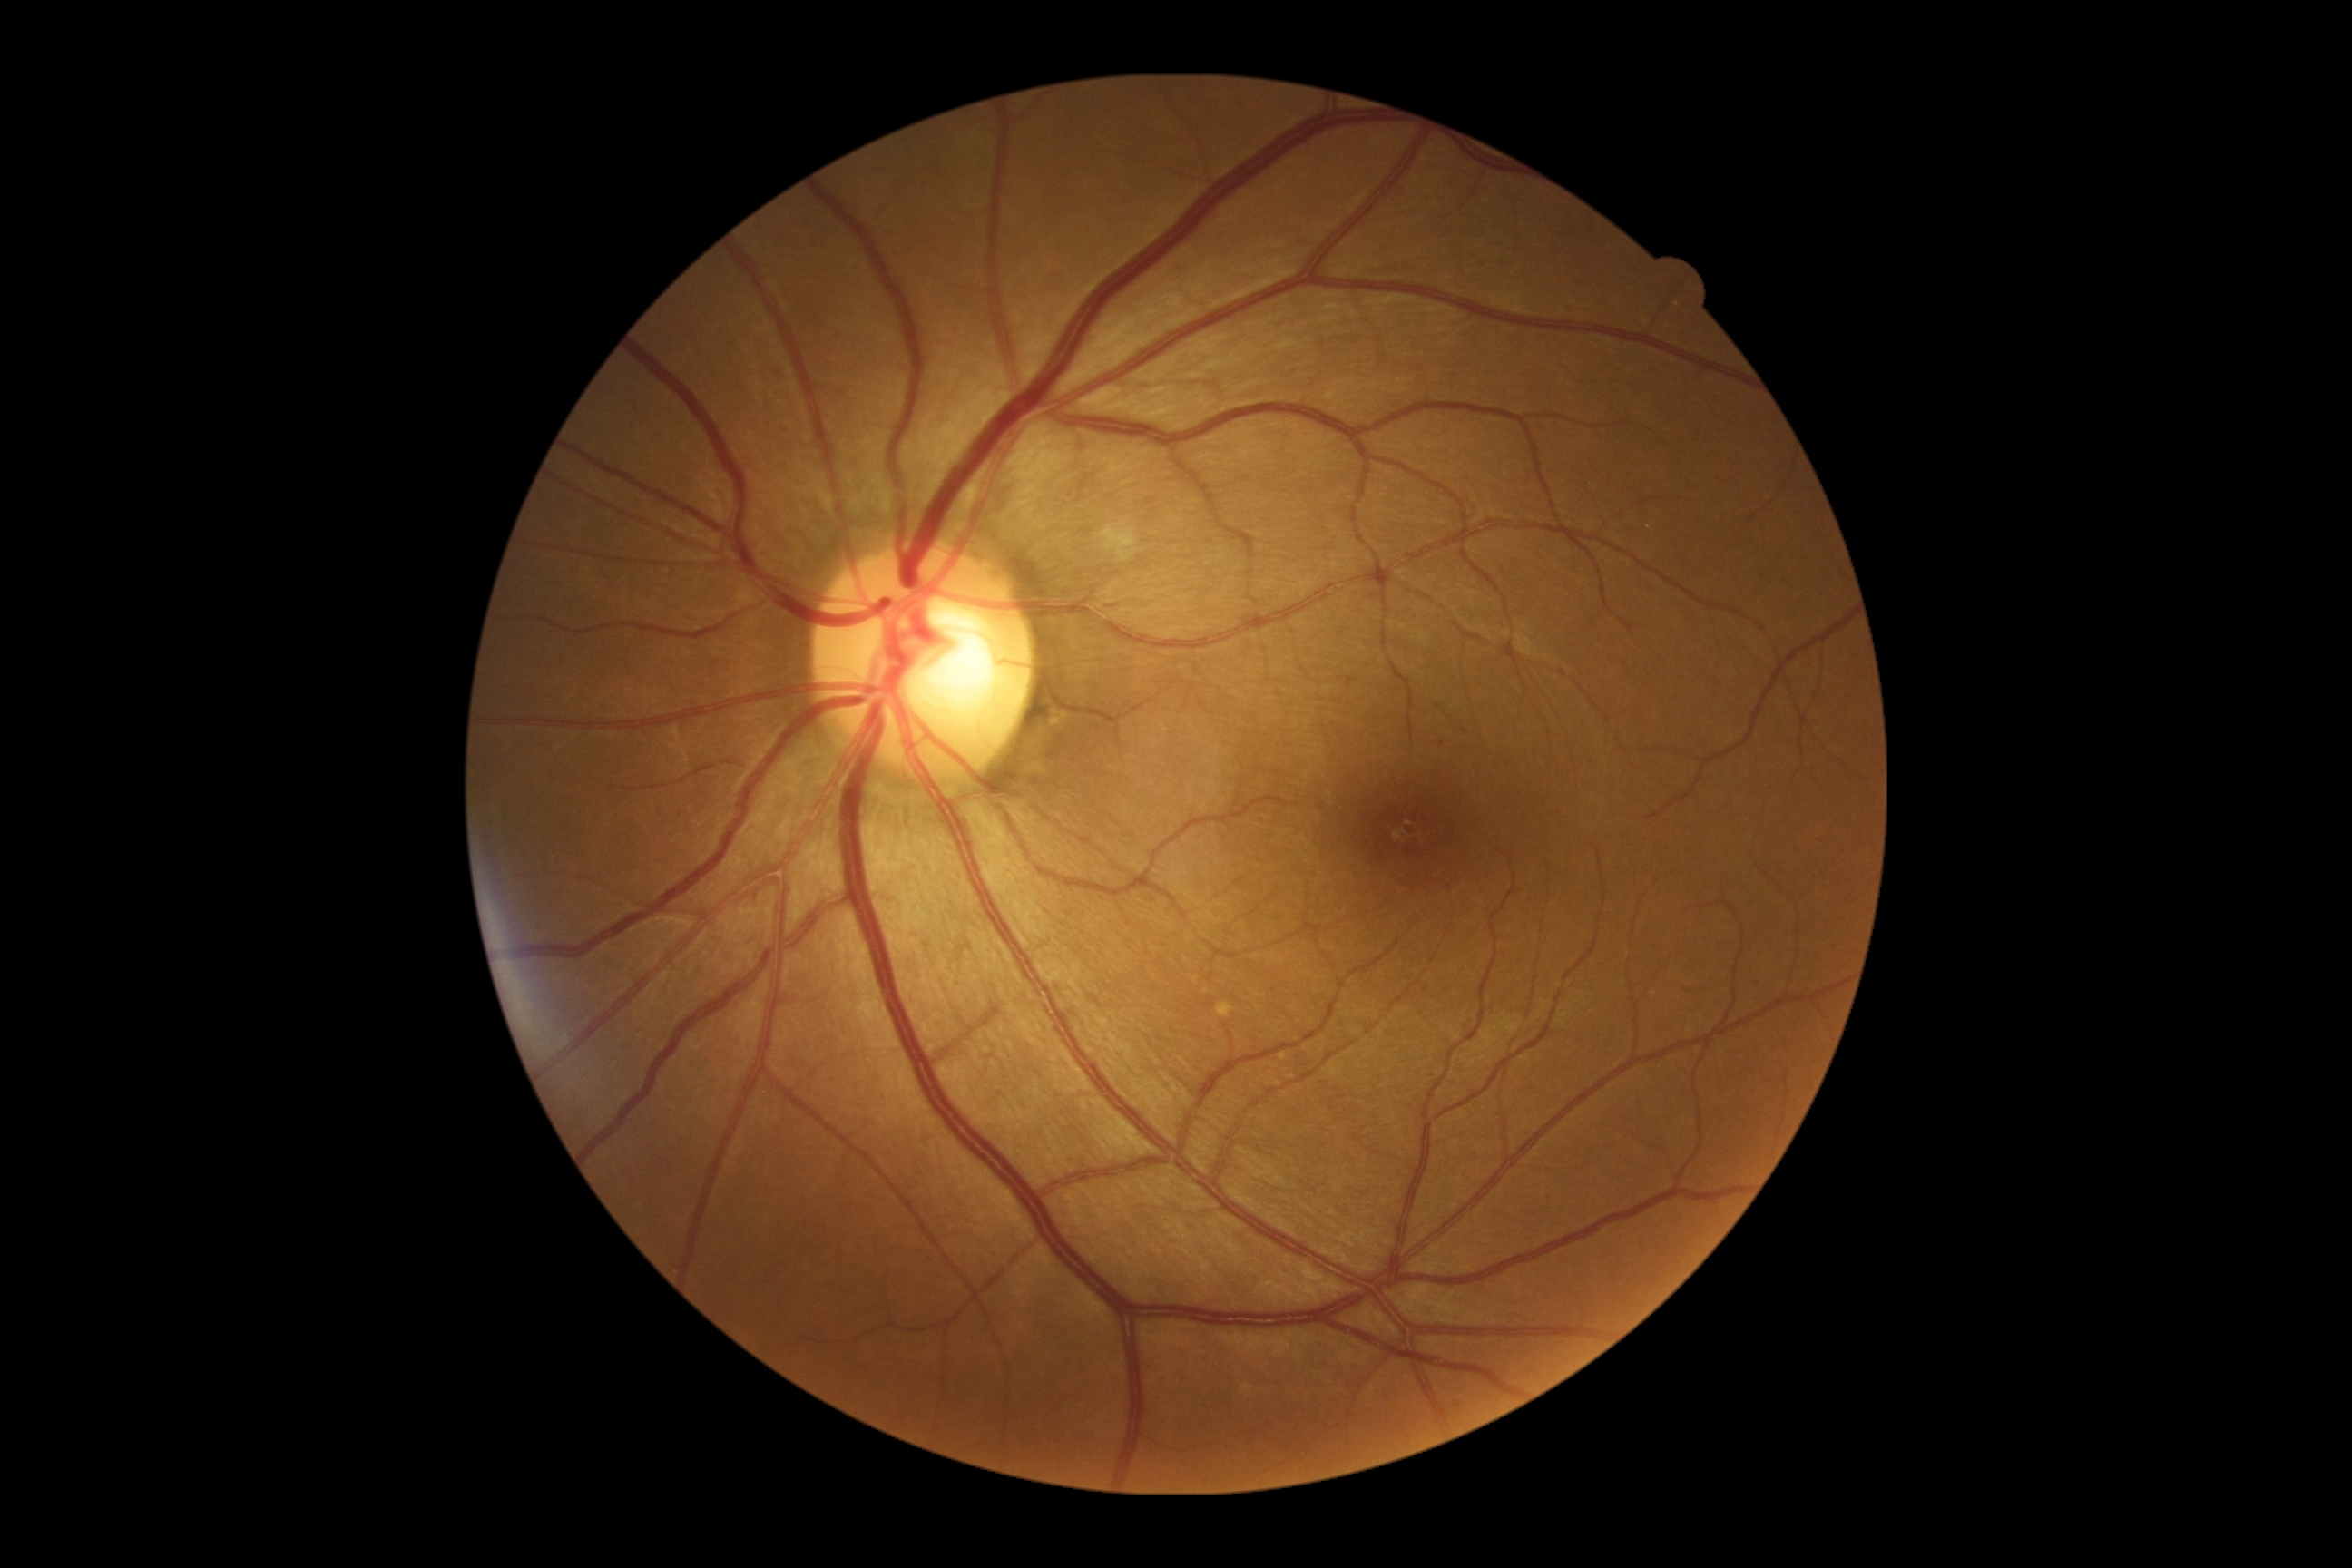 diabetic retinopathy=mild NPDR (grade 1) — presence of microaneurysms only.